CFP — 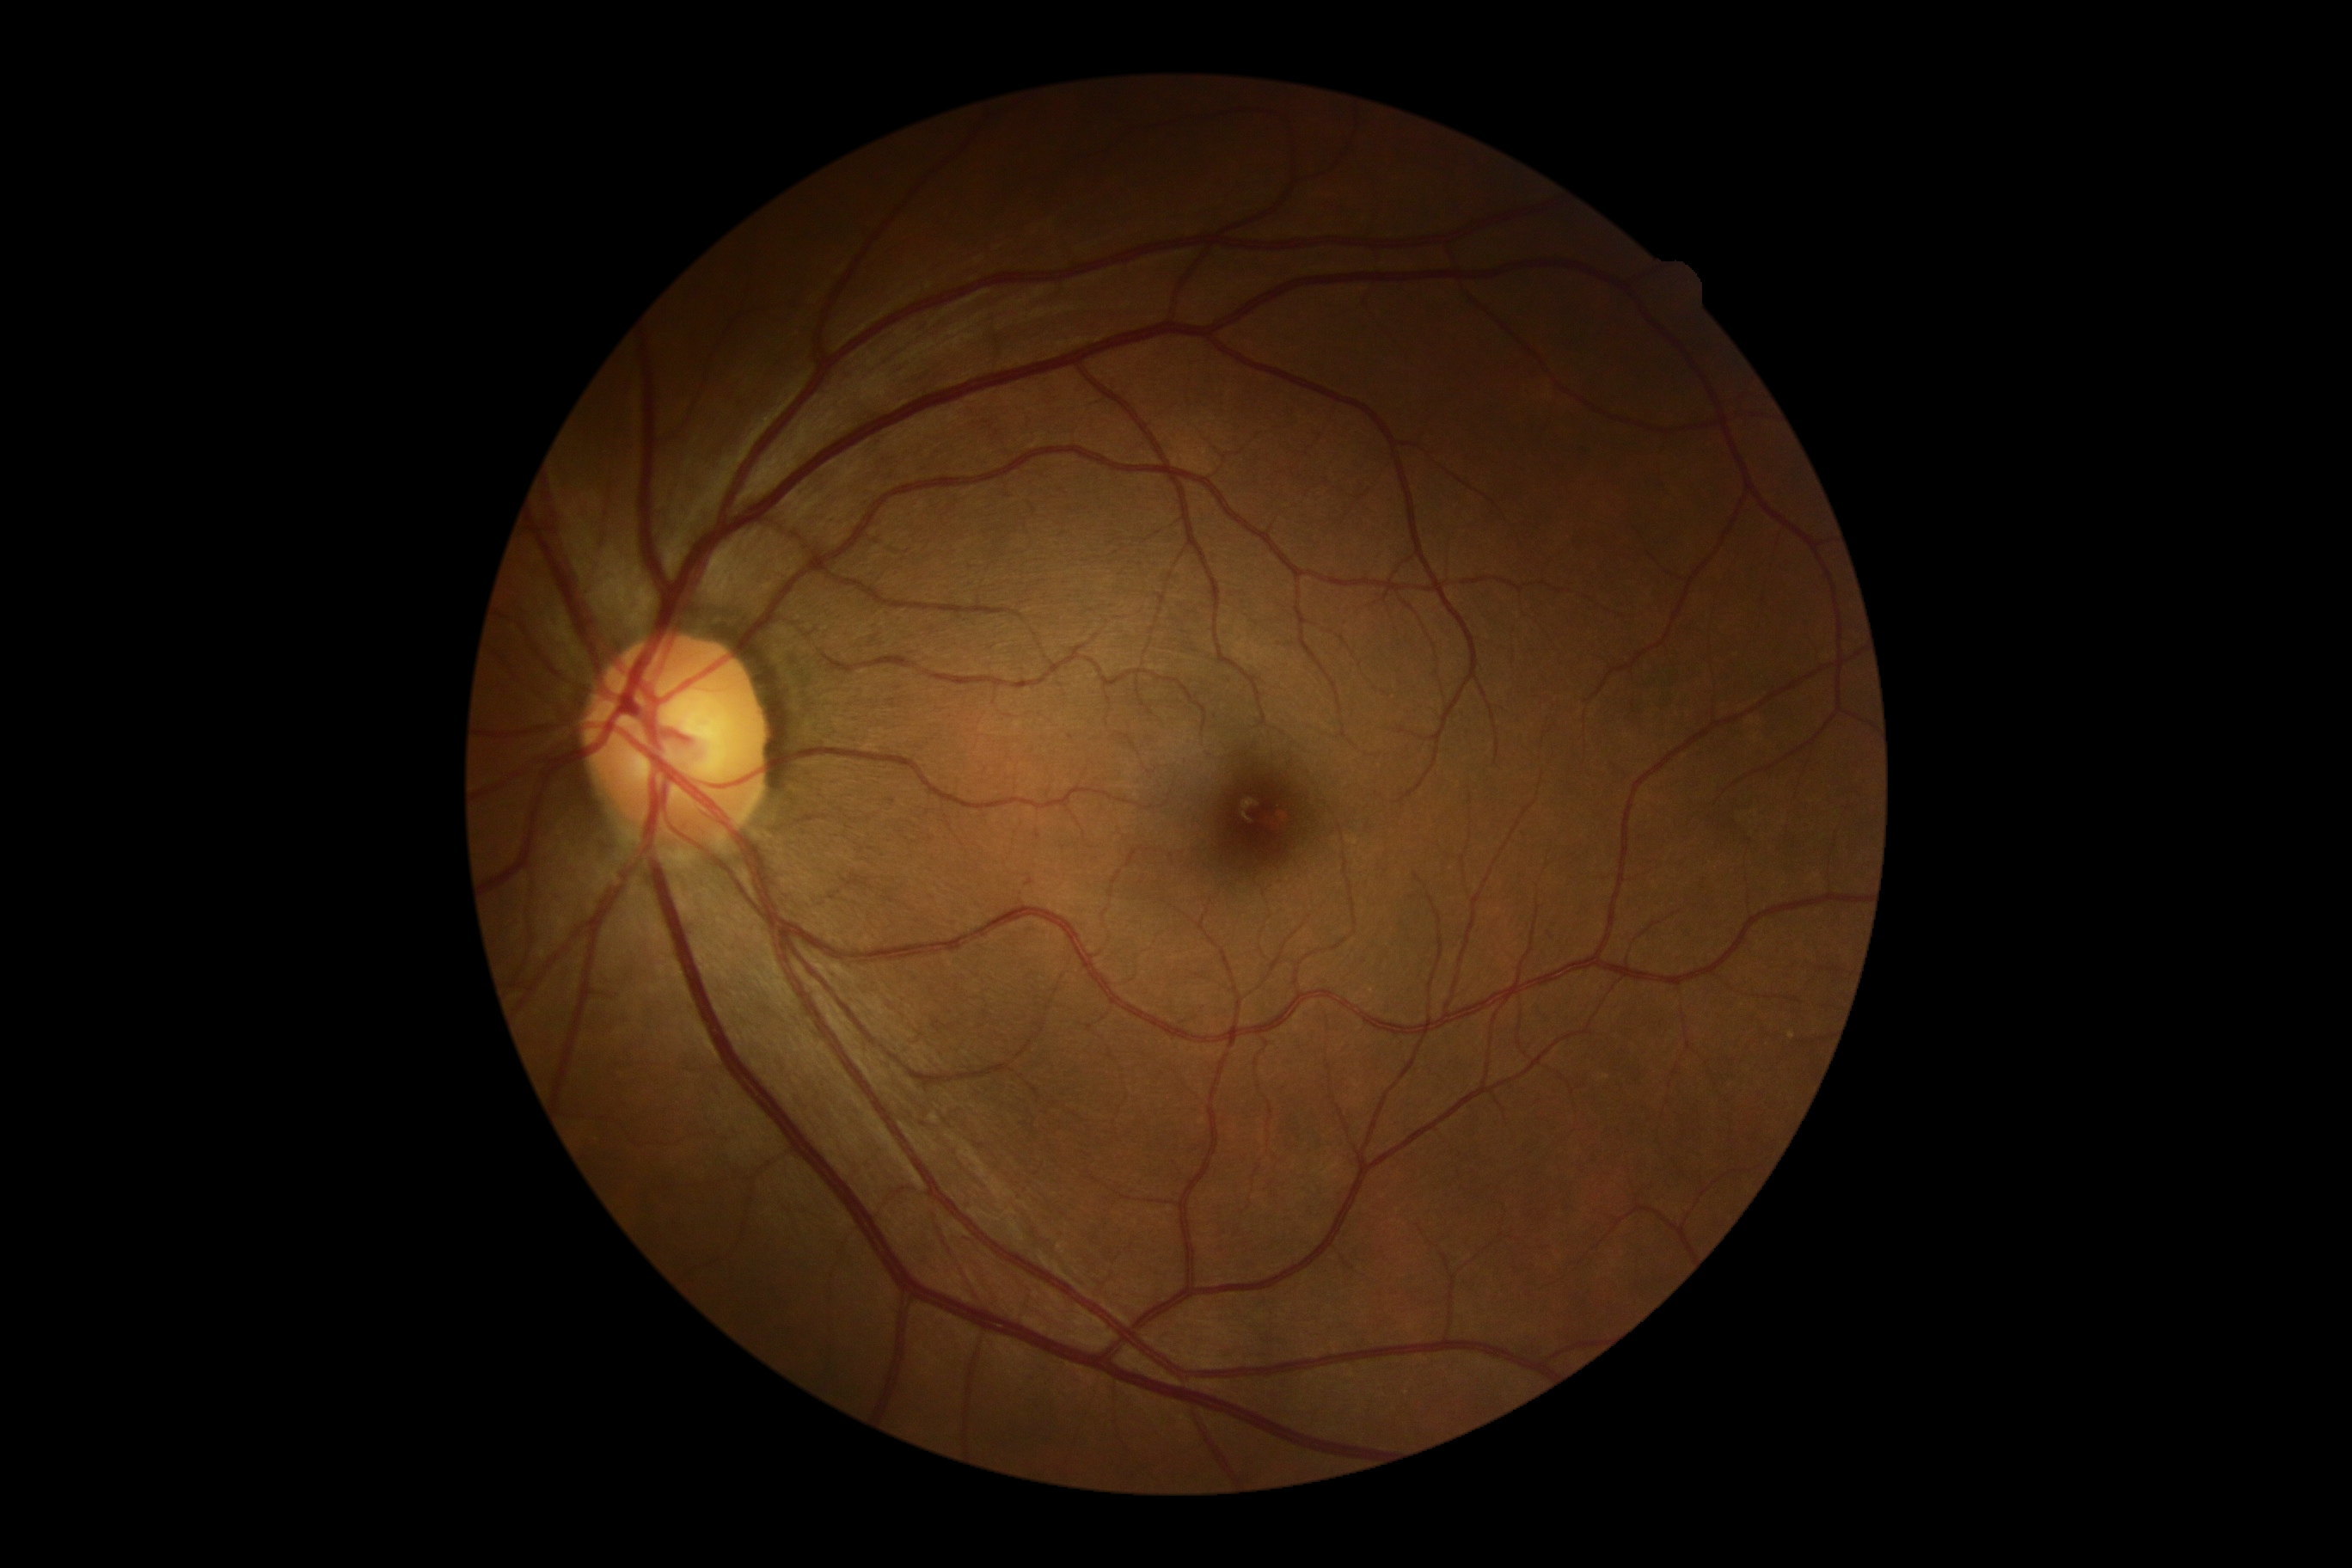
  dr_grade: 0